2352x1568
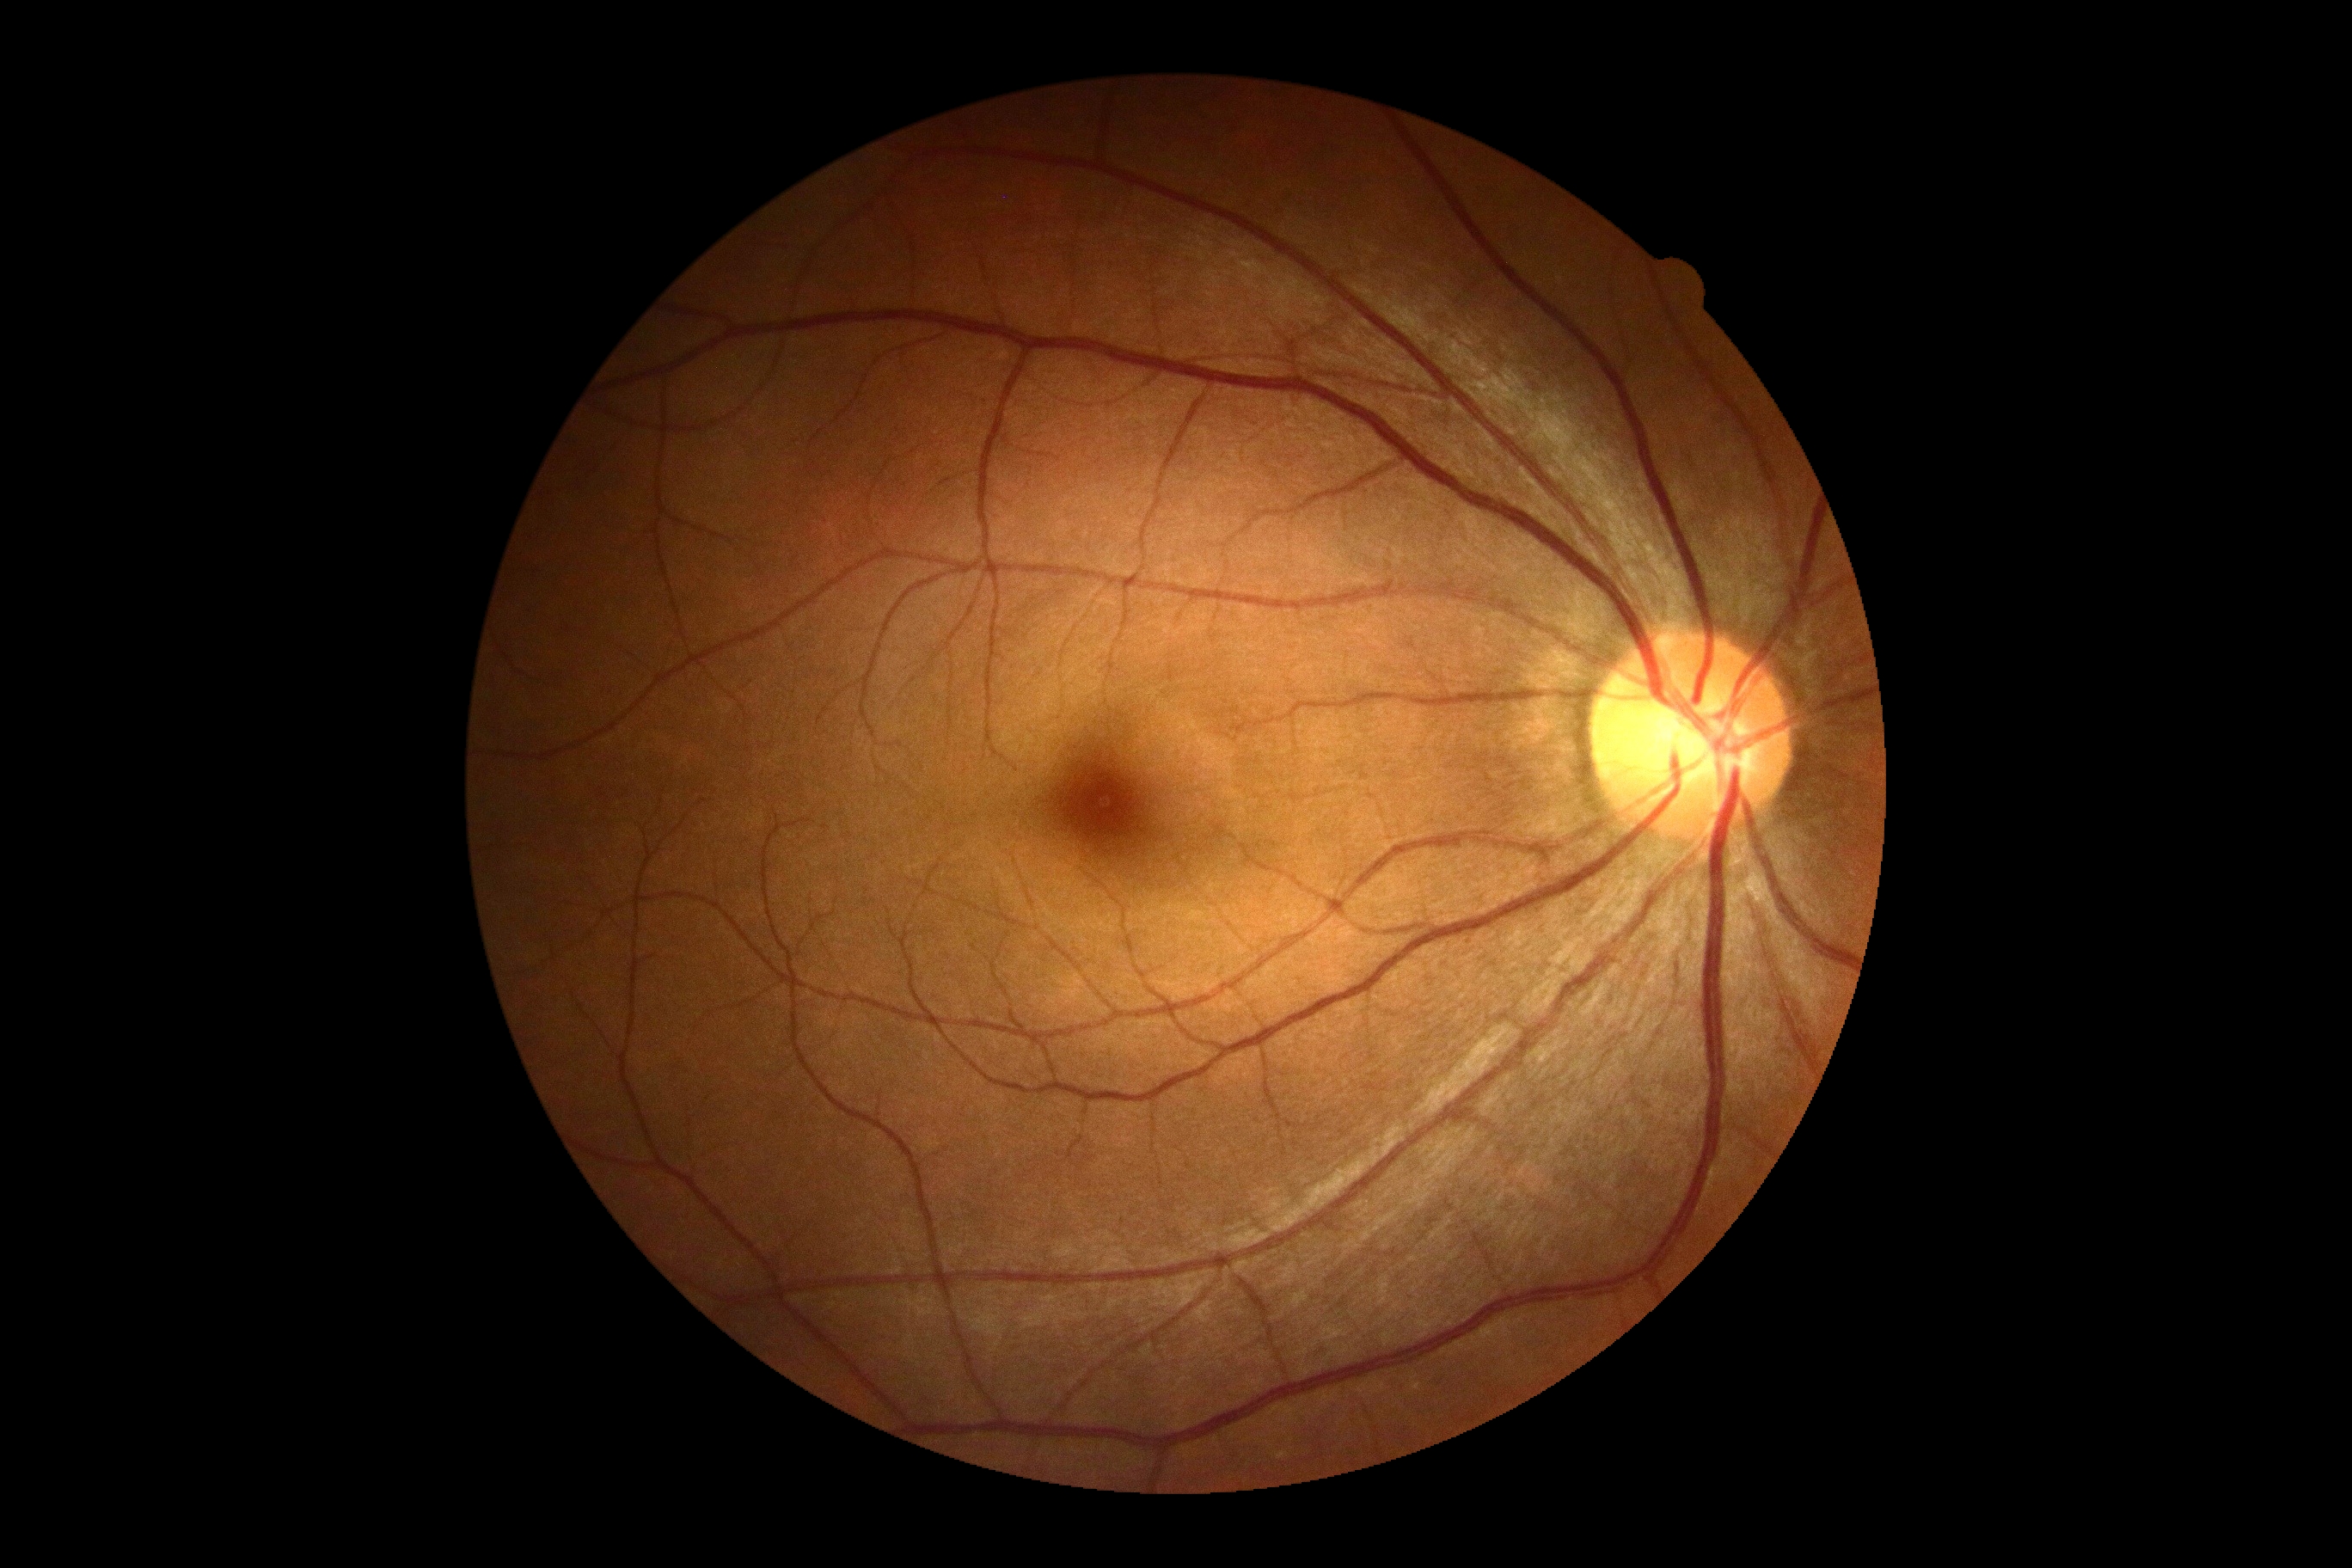
DR severity is no apparent retinopathy (grade 0).